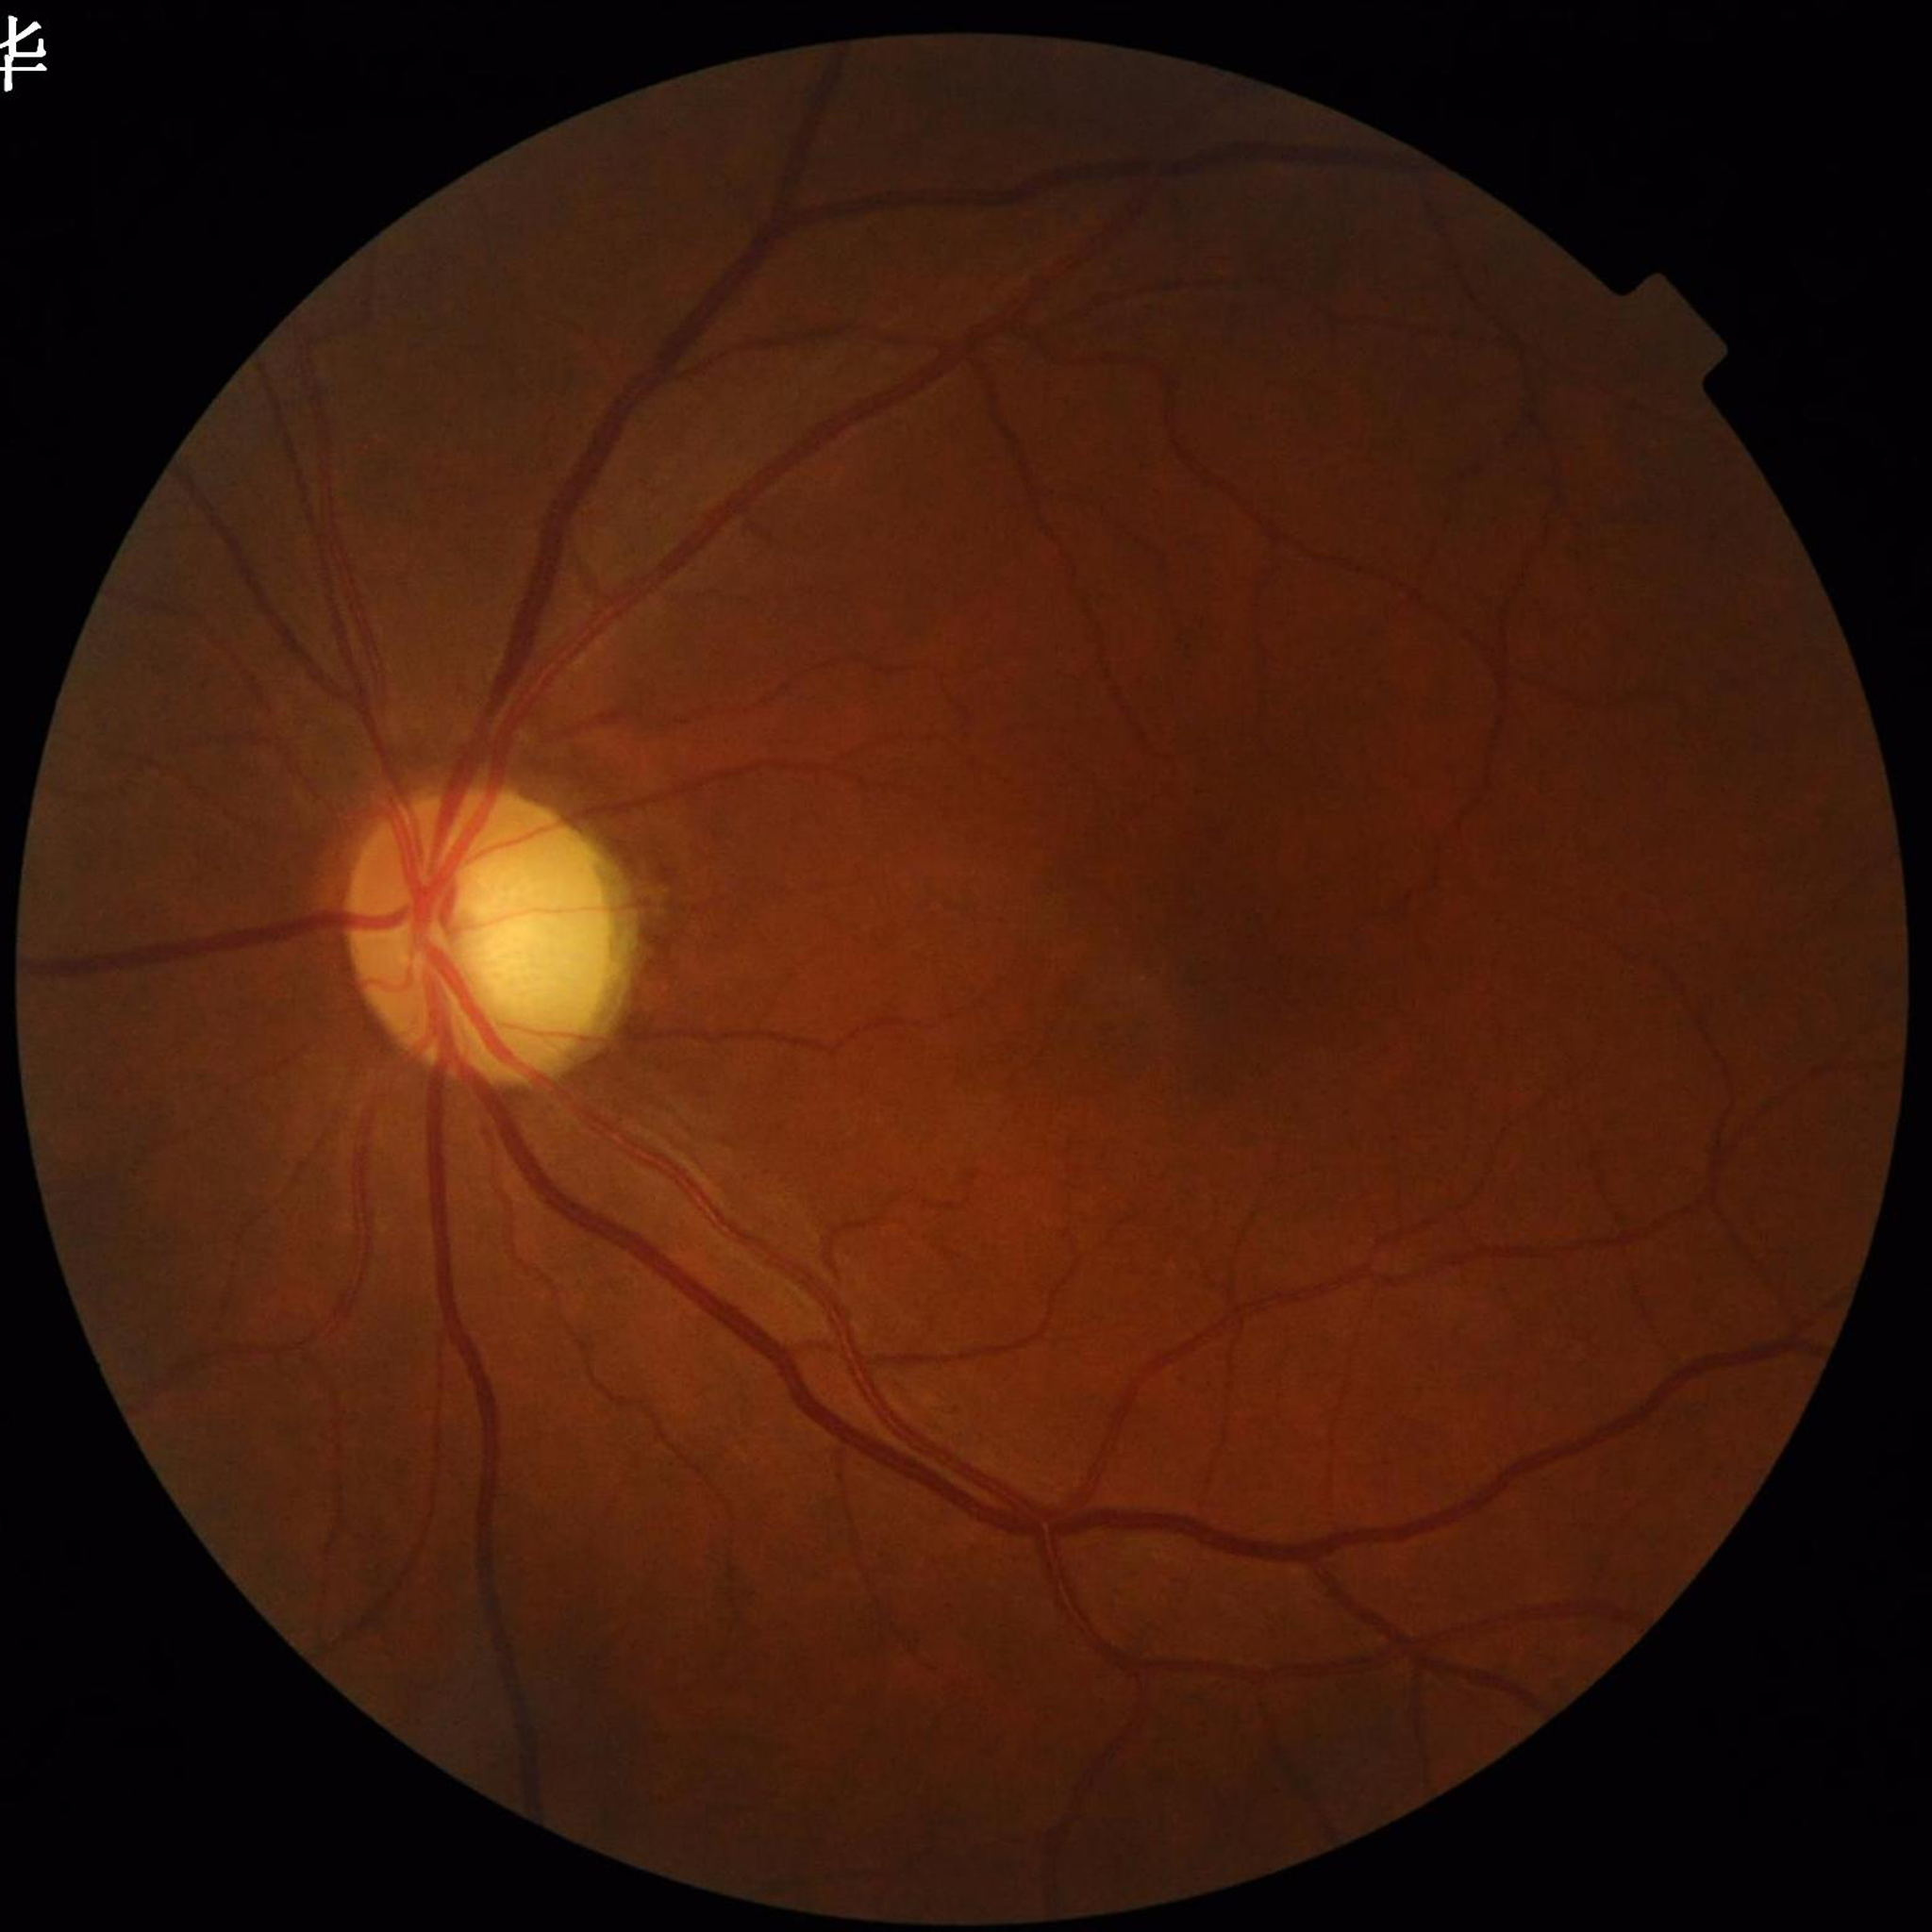

From a patient with glaucoma.